1240x1240px; infant wide-field fundus photograph; captured with the Phoenix ICON (100° field of view)
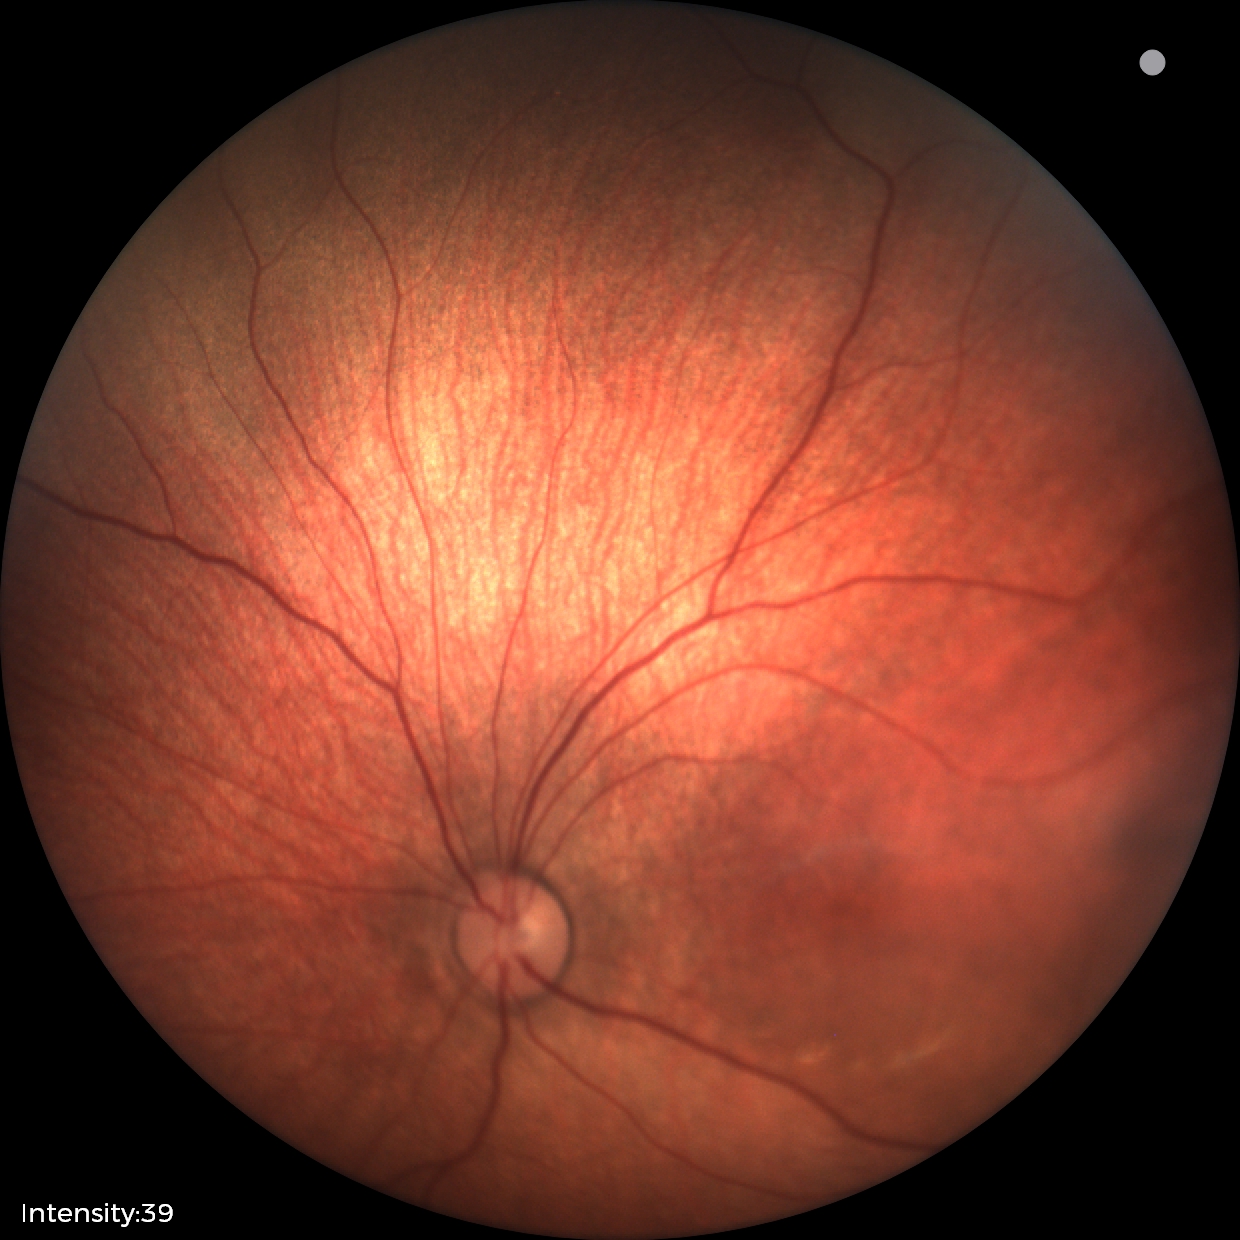
Assessment: no pathology identified.